DR severity per modified Davis staging · no pharmacologic dilation · NIDEK AFC-230 fundus camera — 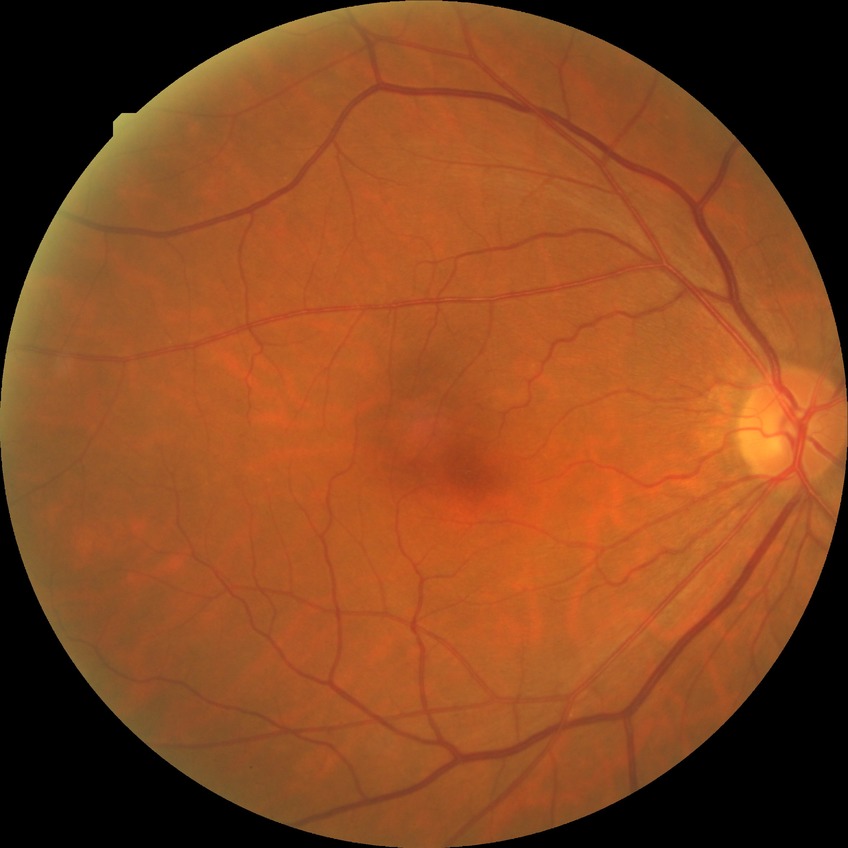 modified Davis grading: no diabetic retinopathy.